2212 by 1672 pixels: 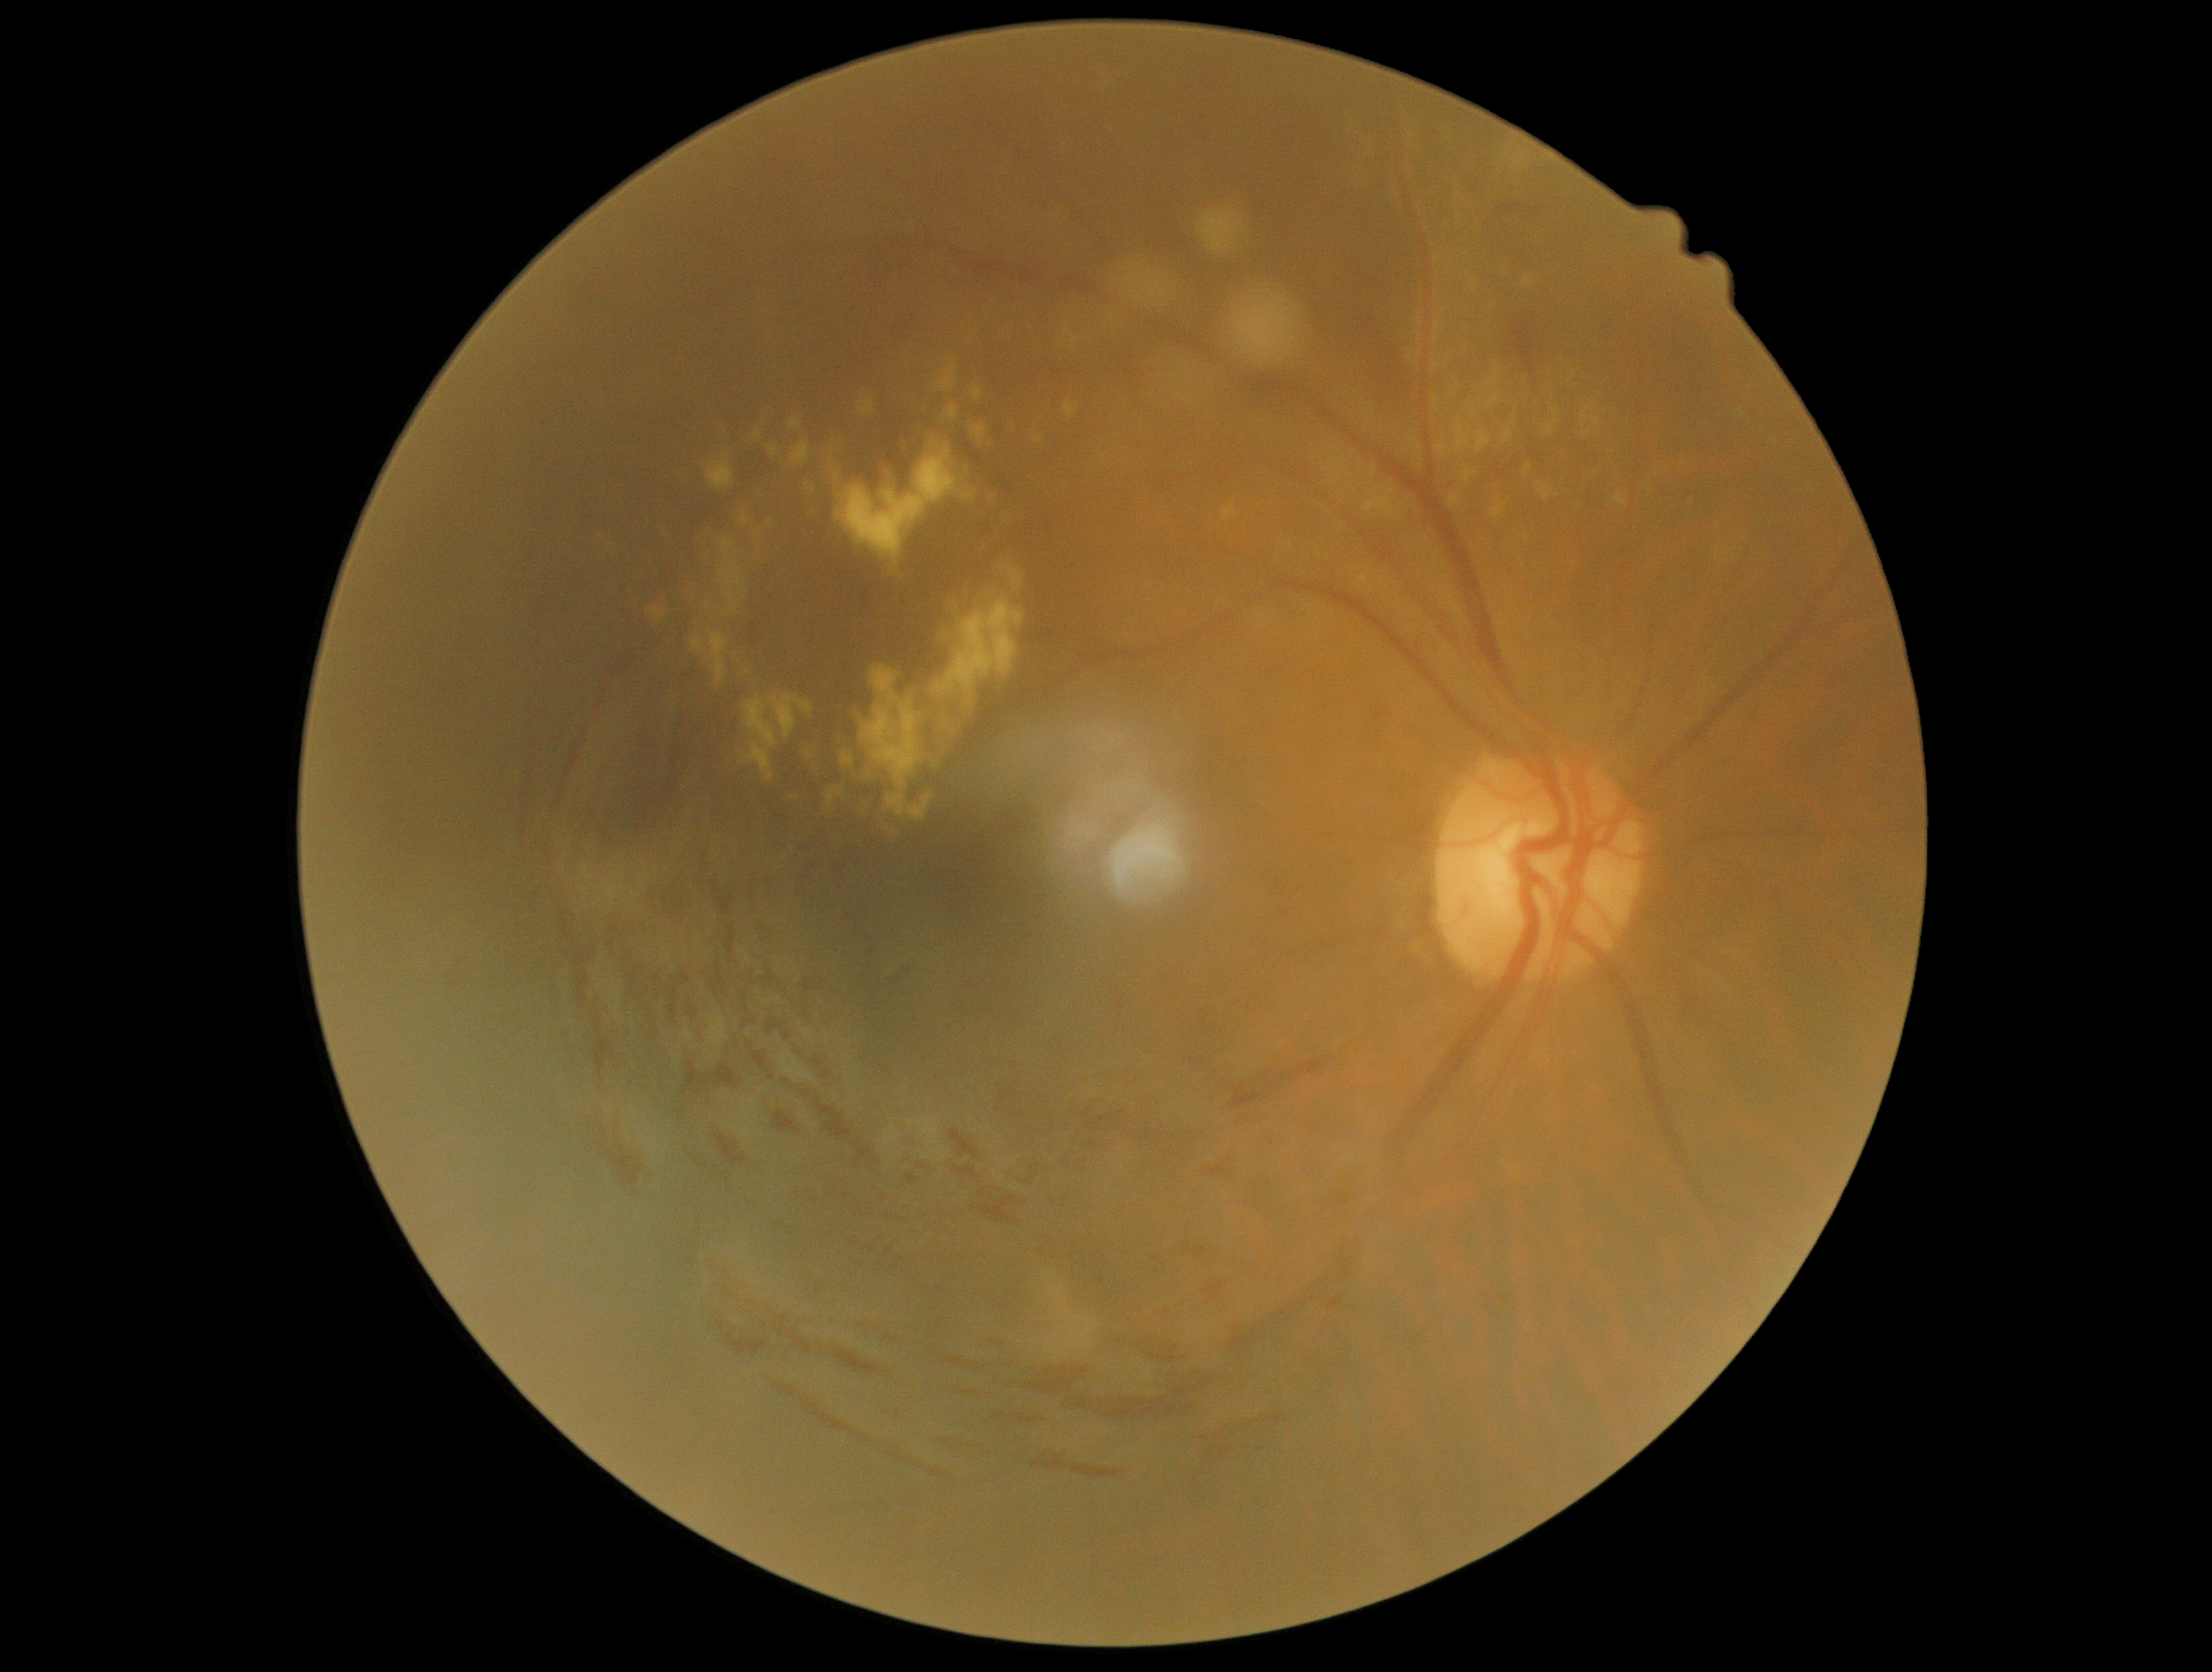
Diabetic retinopathy (DR) is 2/4.